Image size 1659x2212: 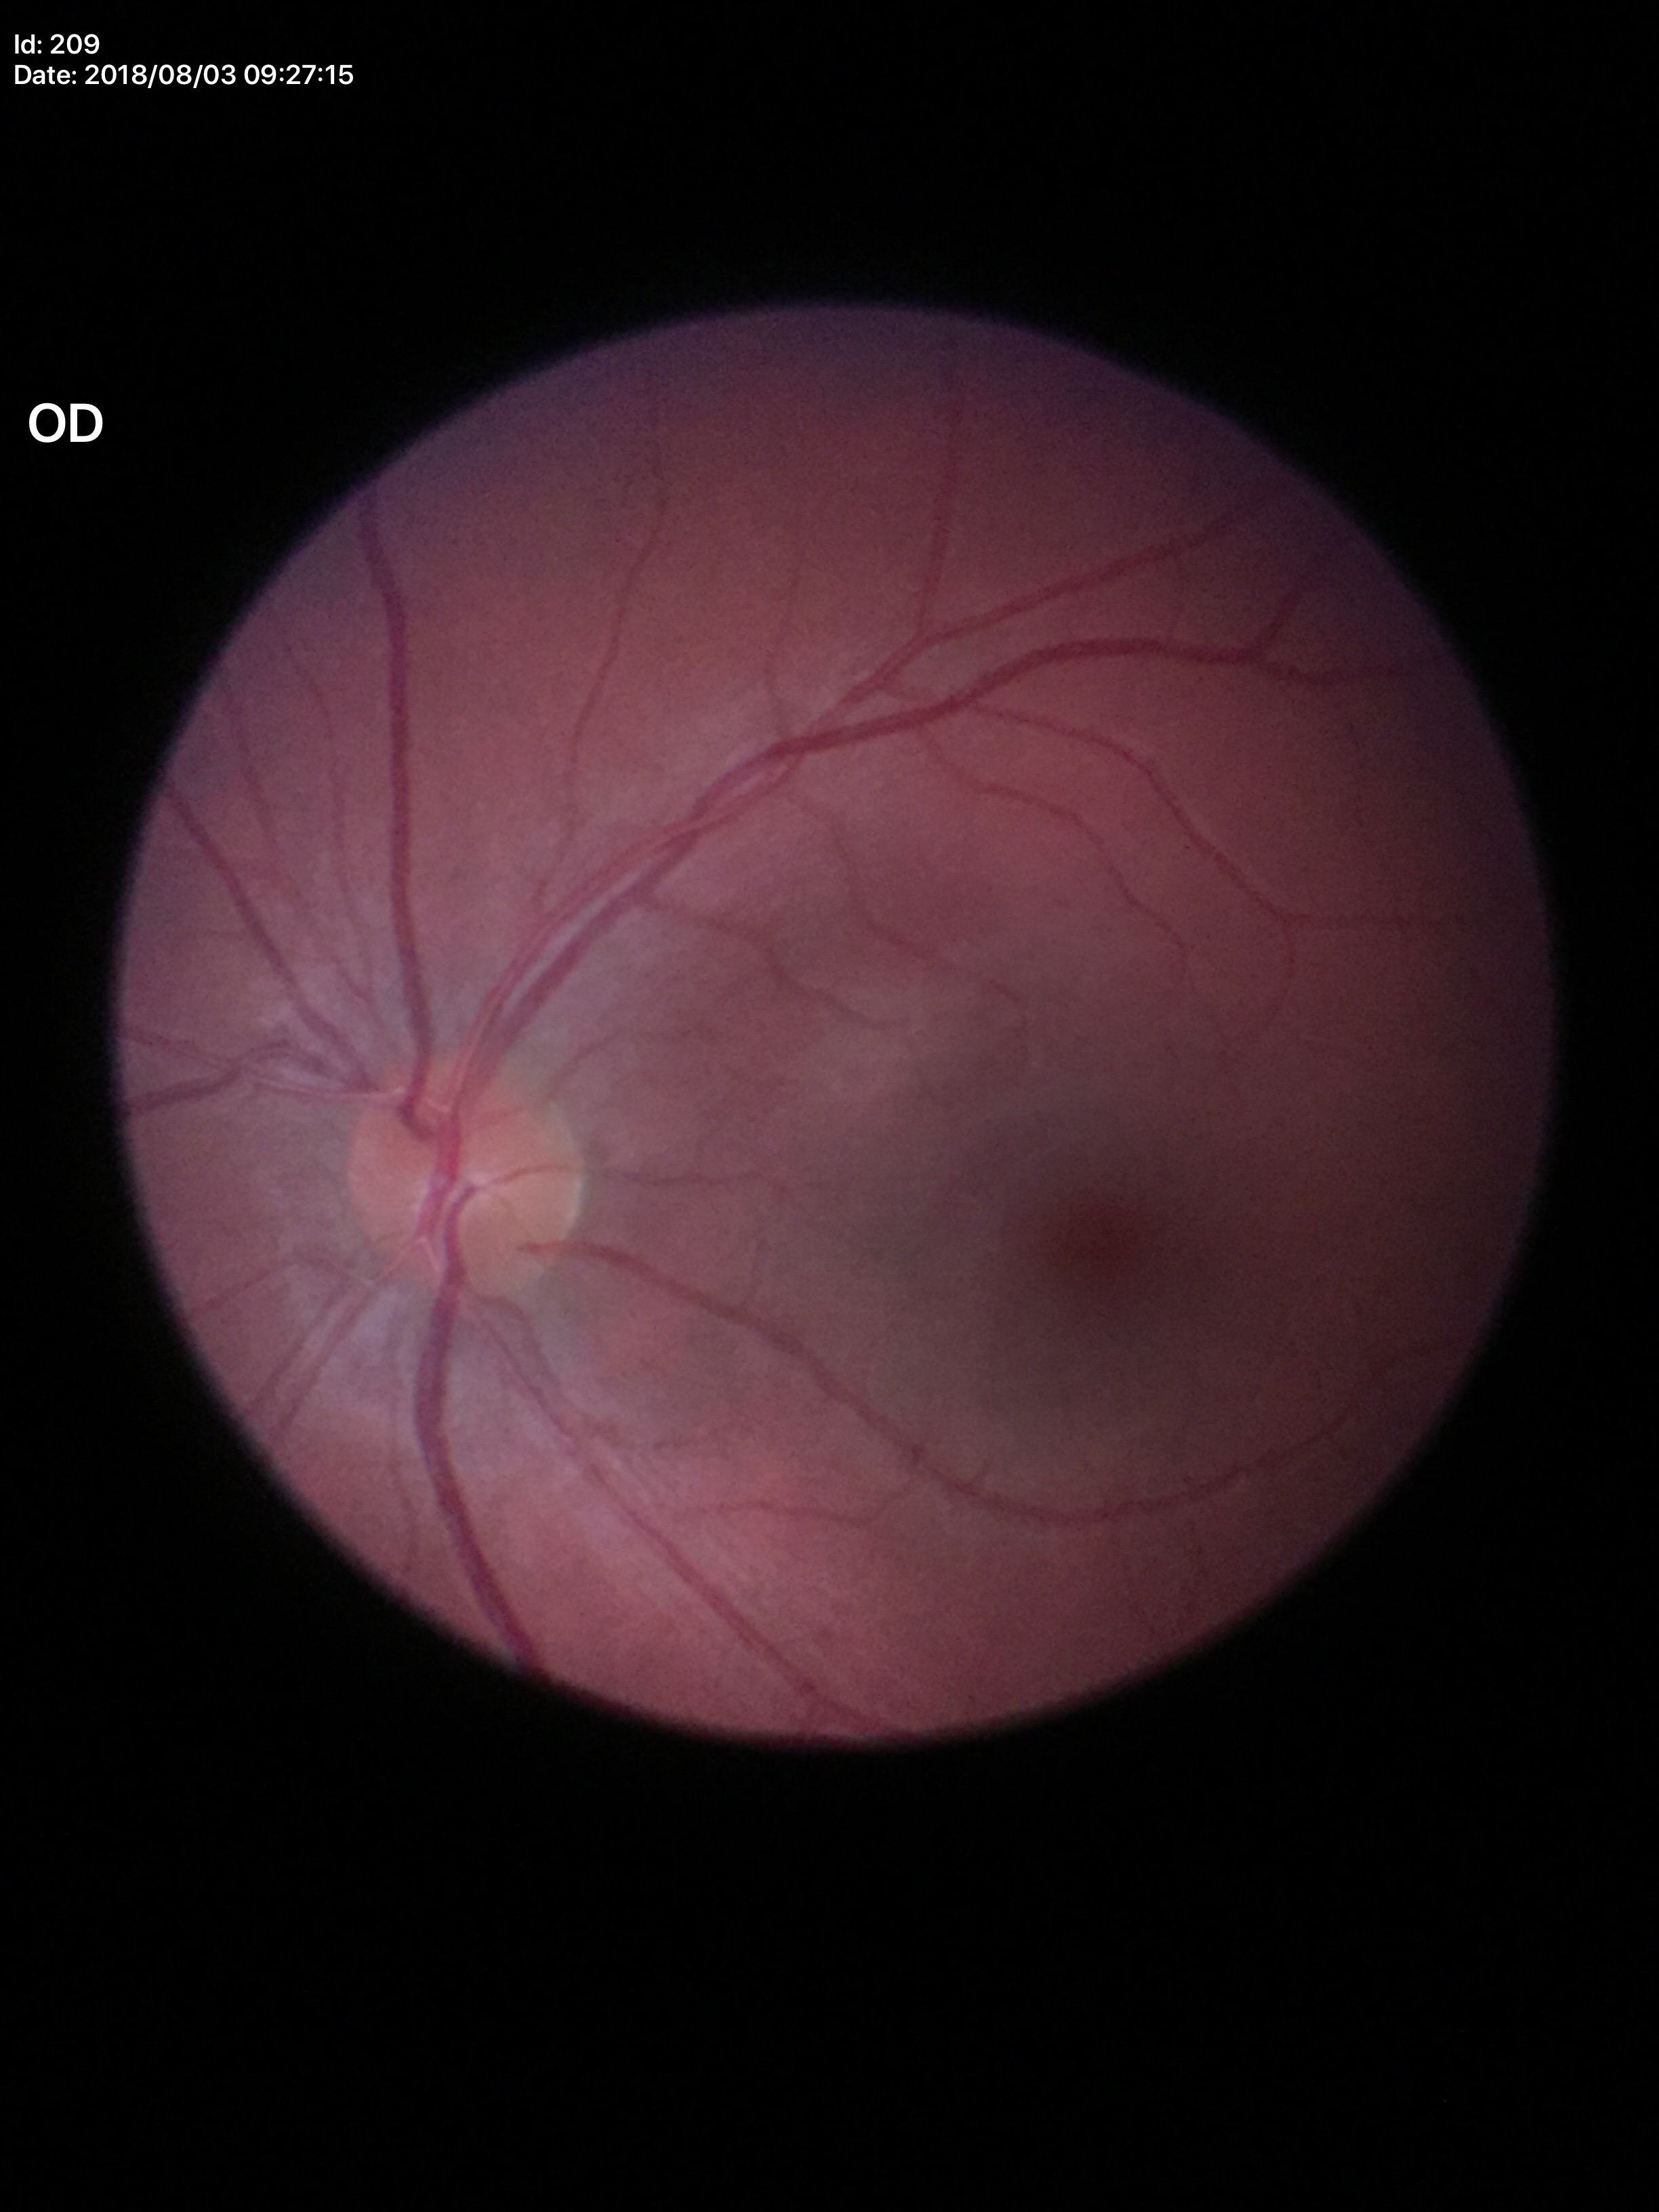 VCDR: 0.26.
Glaucoma assessment: negative.